Image size 2212x1659, retinal fundus photograph — 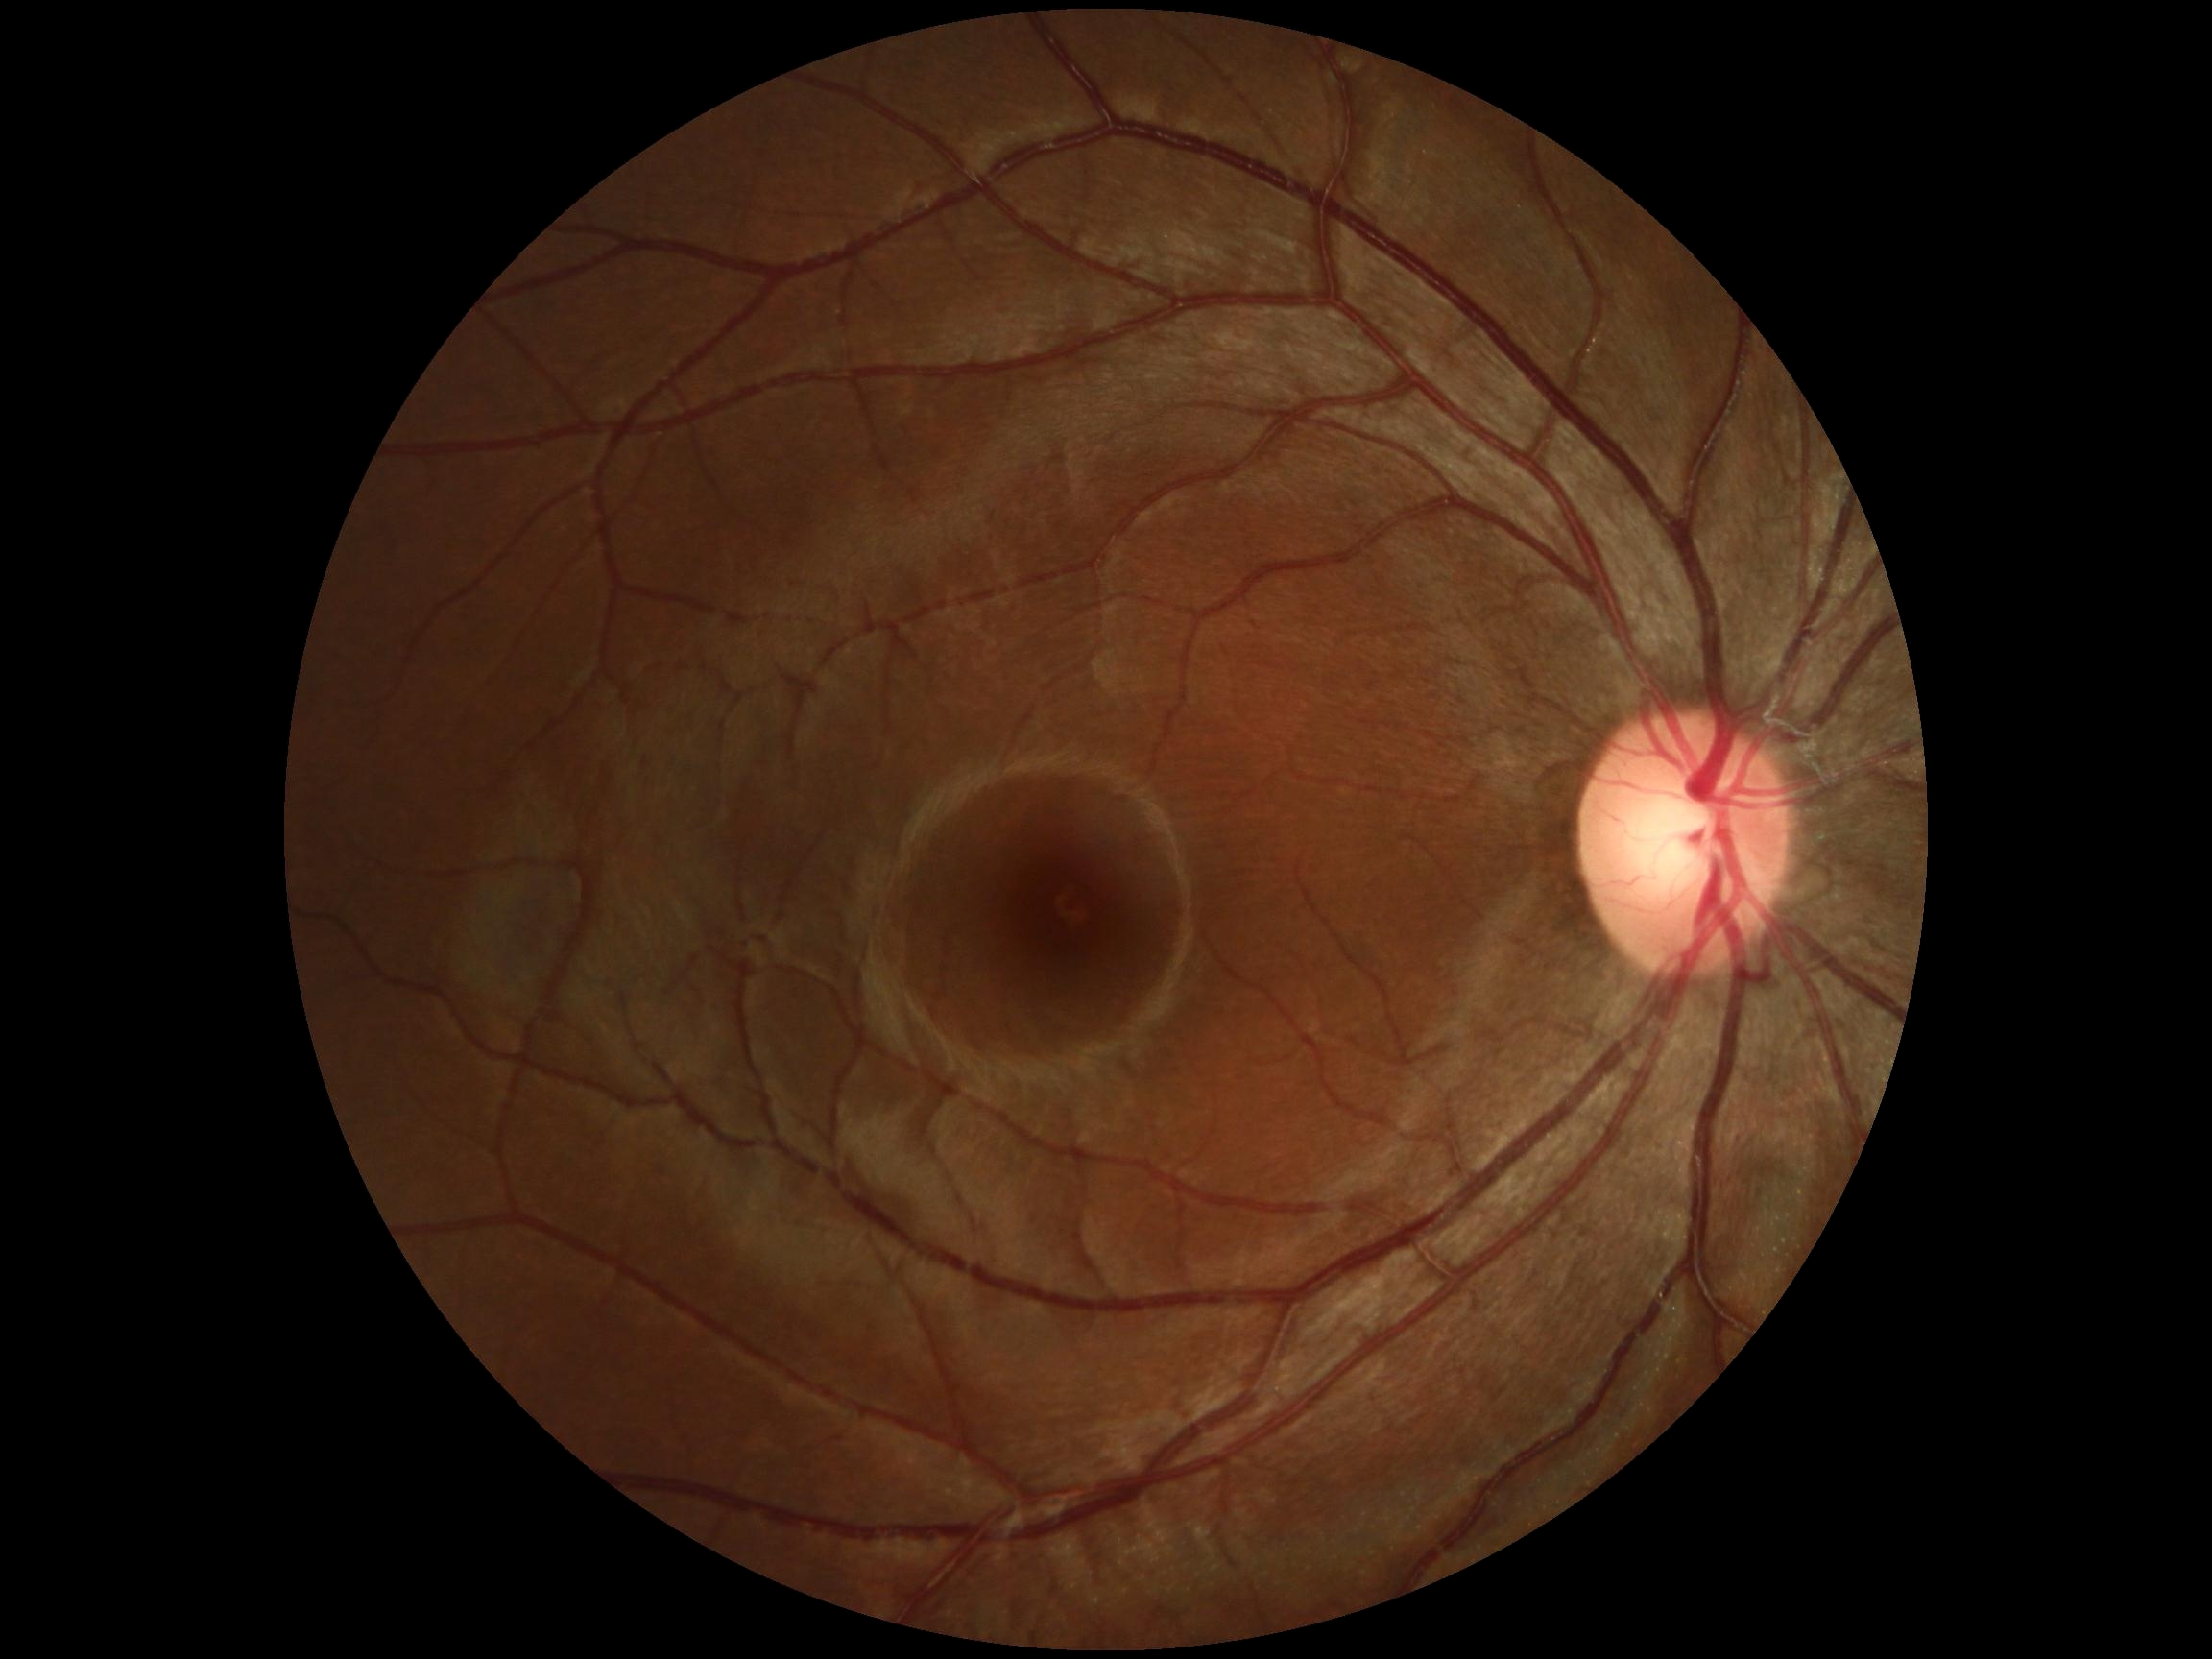 diabetic retinopathy (DR): grade 0 (no apparent retinopathy) — no visible signs of diabetic retinopathy.